Posterior pole photograph · acquired with a NIDEK AFC-230 · without pupil dilation · FOV: 45 degrees · 848x848 — 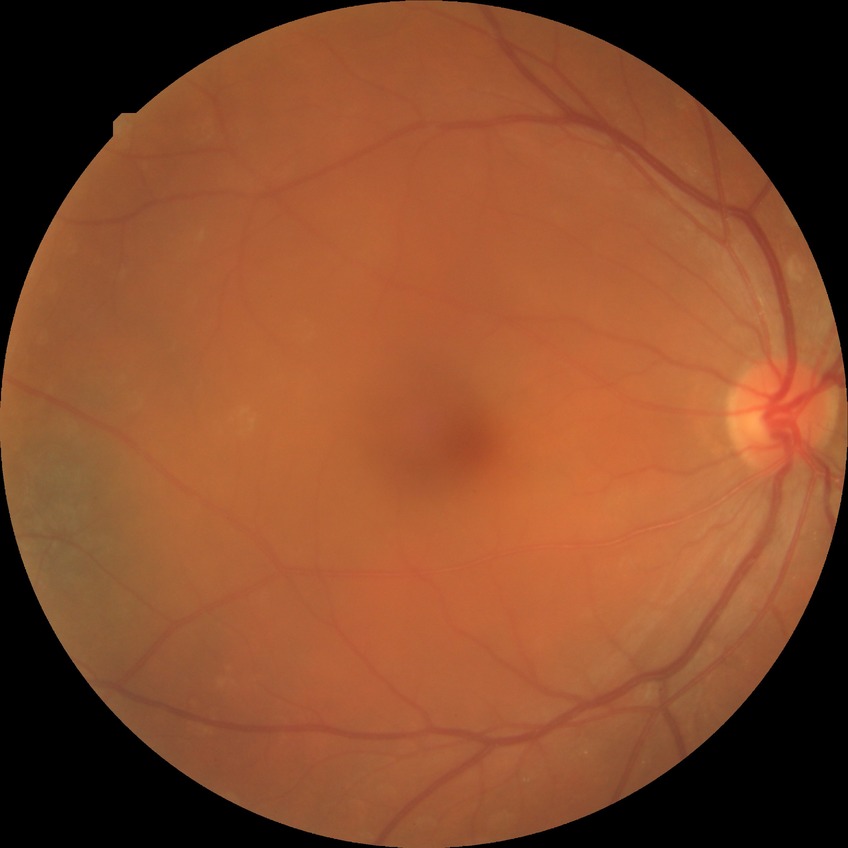
diabetic retinopathy (DR): SDR (simple diabetic retinopathy)
DR class: non-proliferative diabetic retinopathy